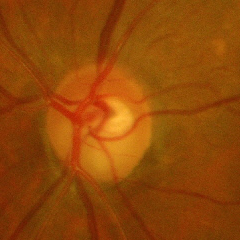 Q: Glaucoma assessment?
A: Yes — advanced glaucoma.